CFP — 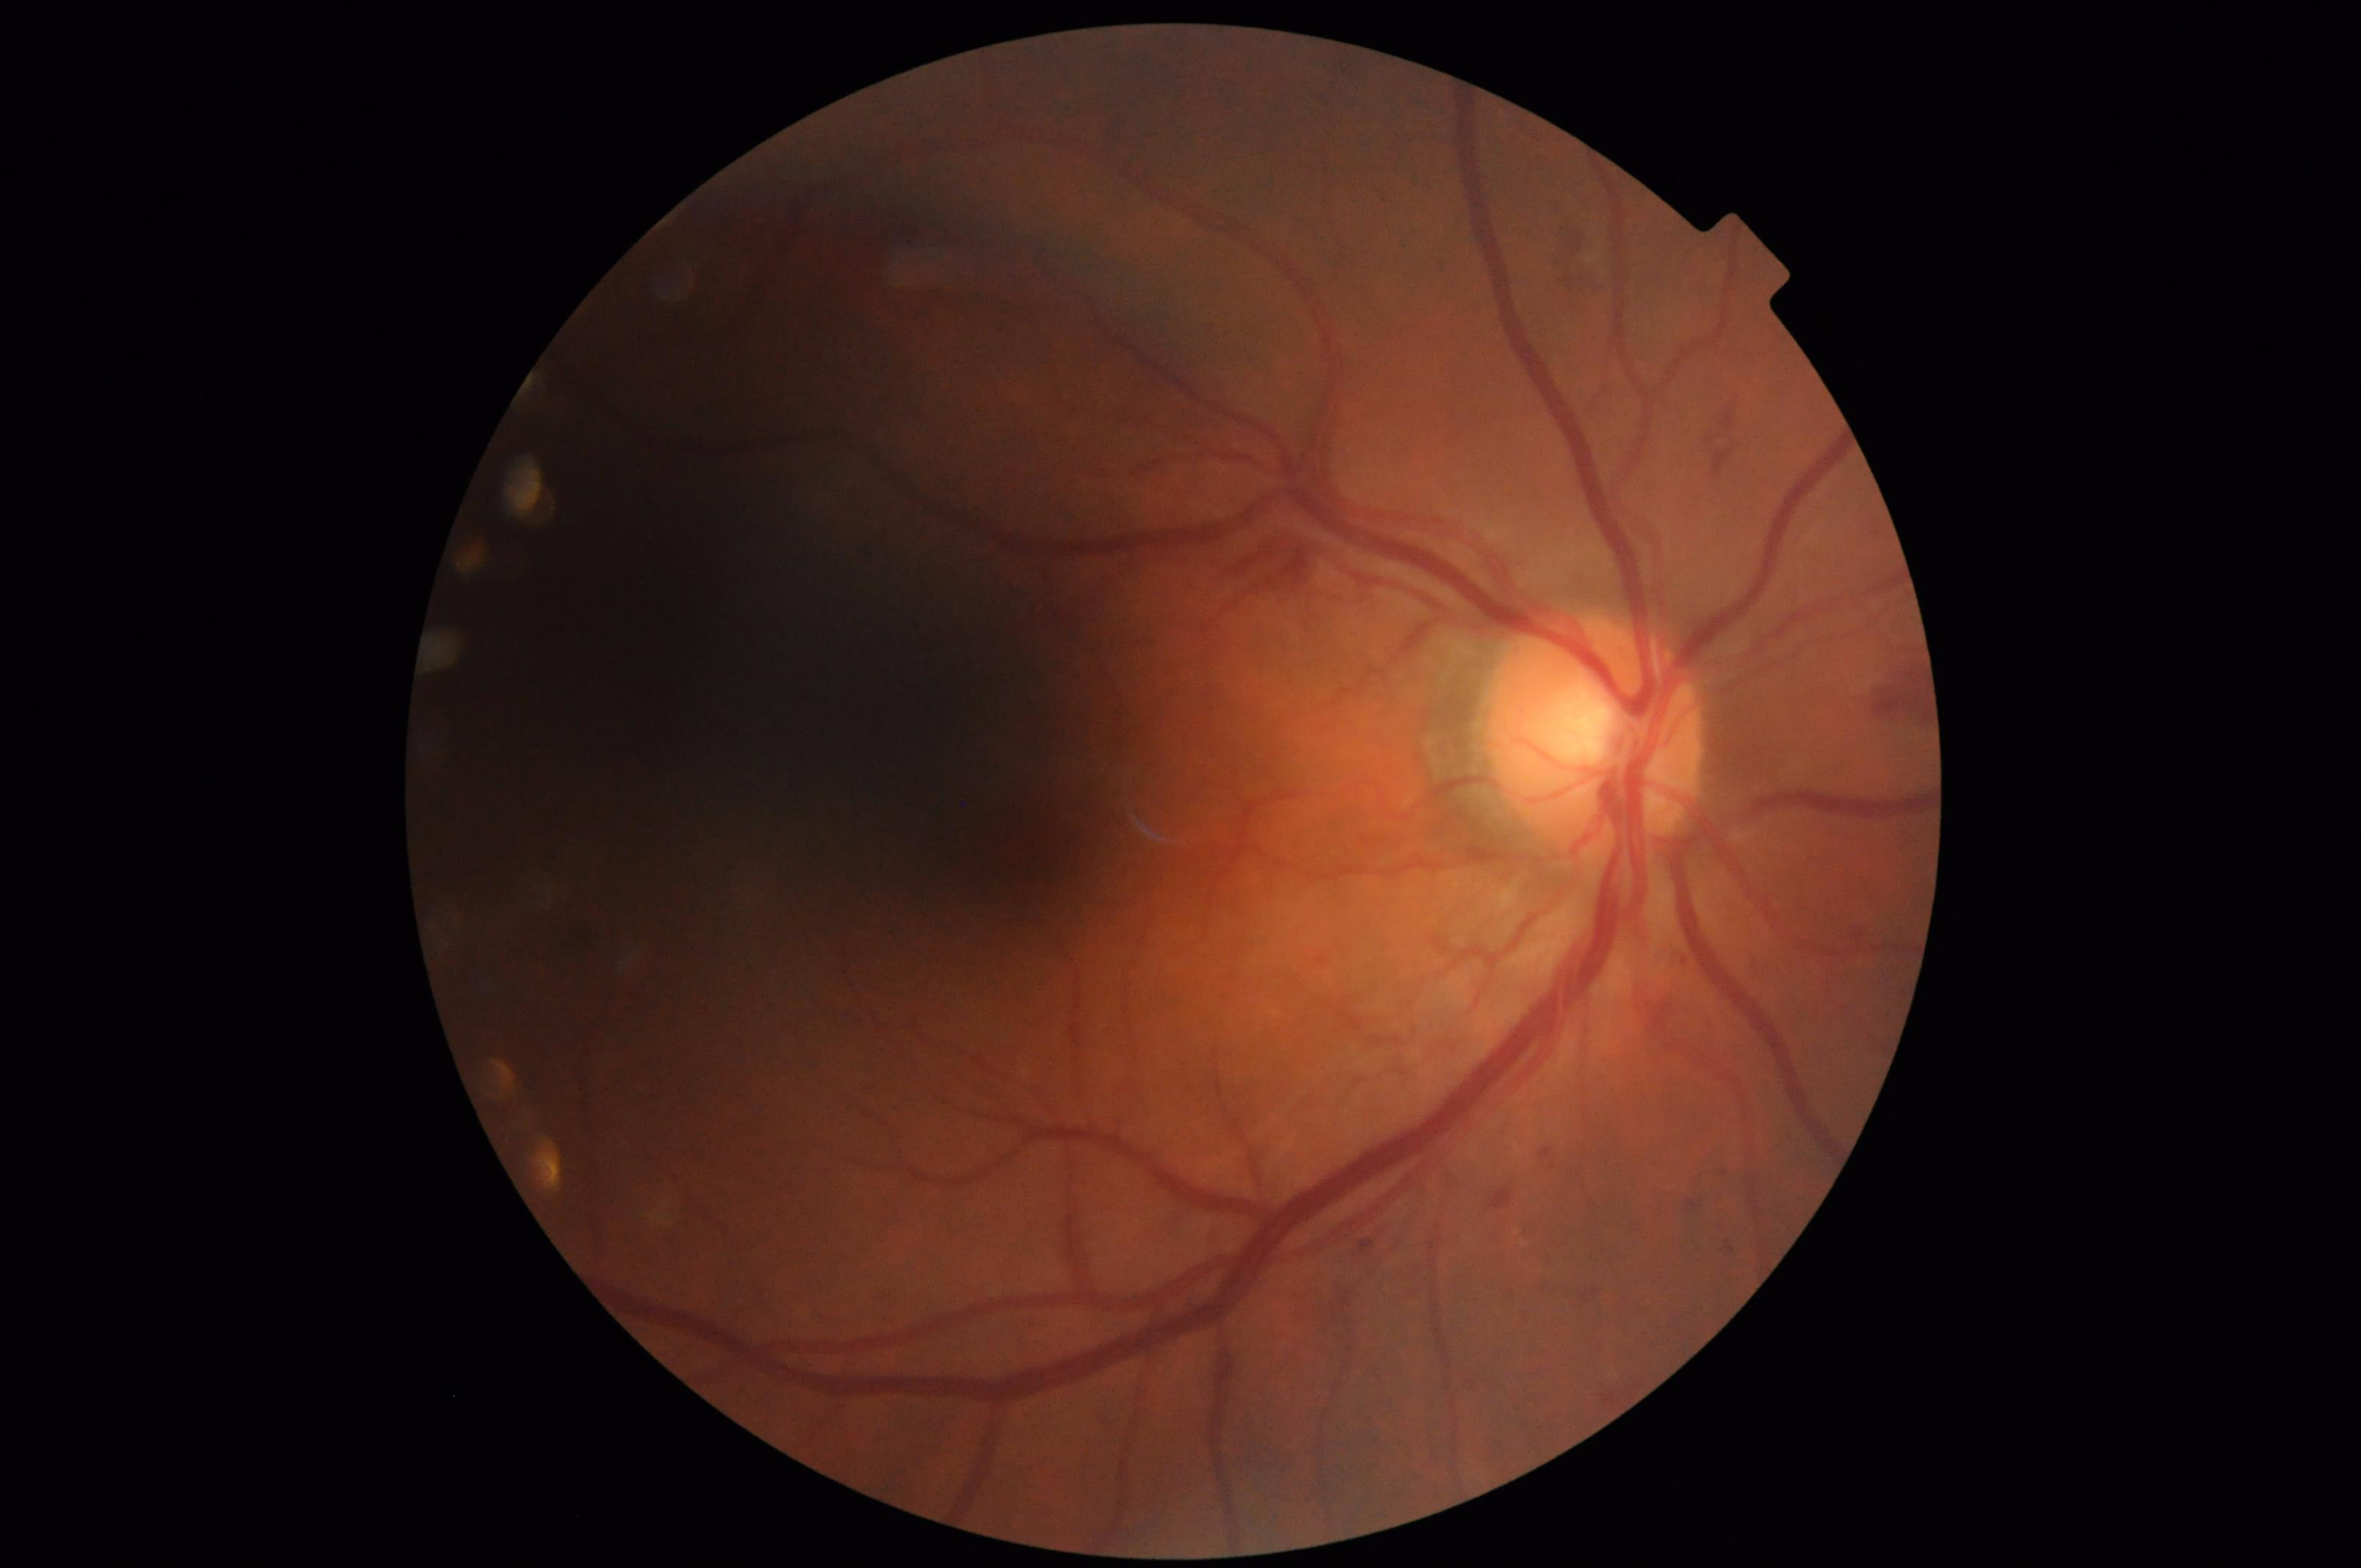

Quality grading: focus: sharp | contrast: adequate | overall: low | illumination/color: uneven.